45-degree field of view. Fundus photo.
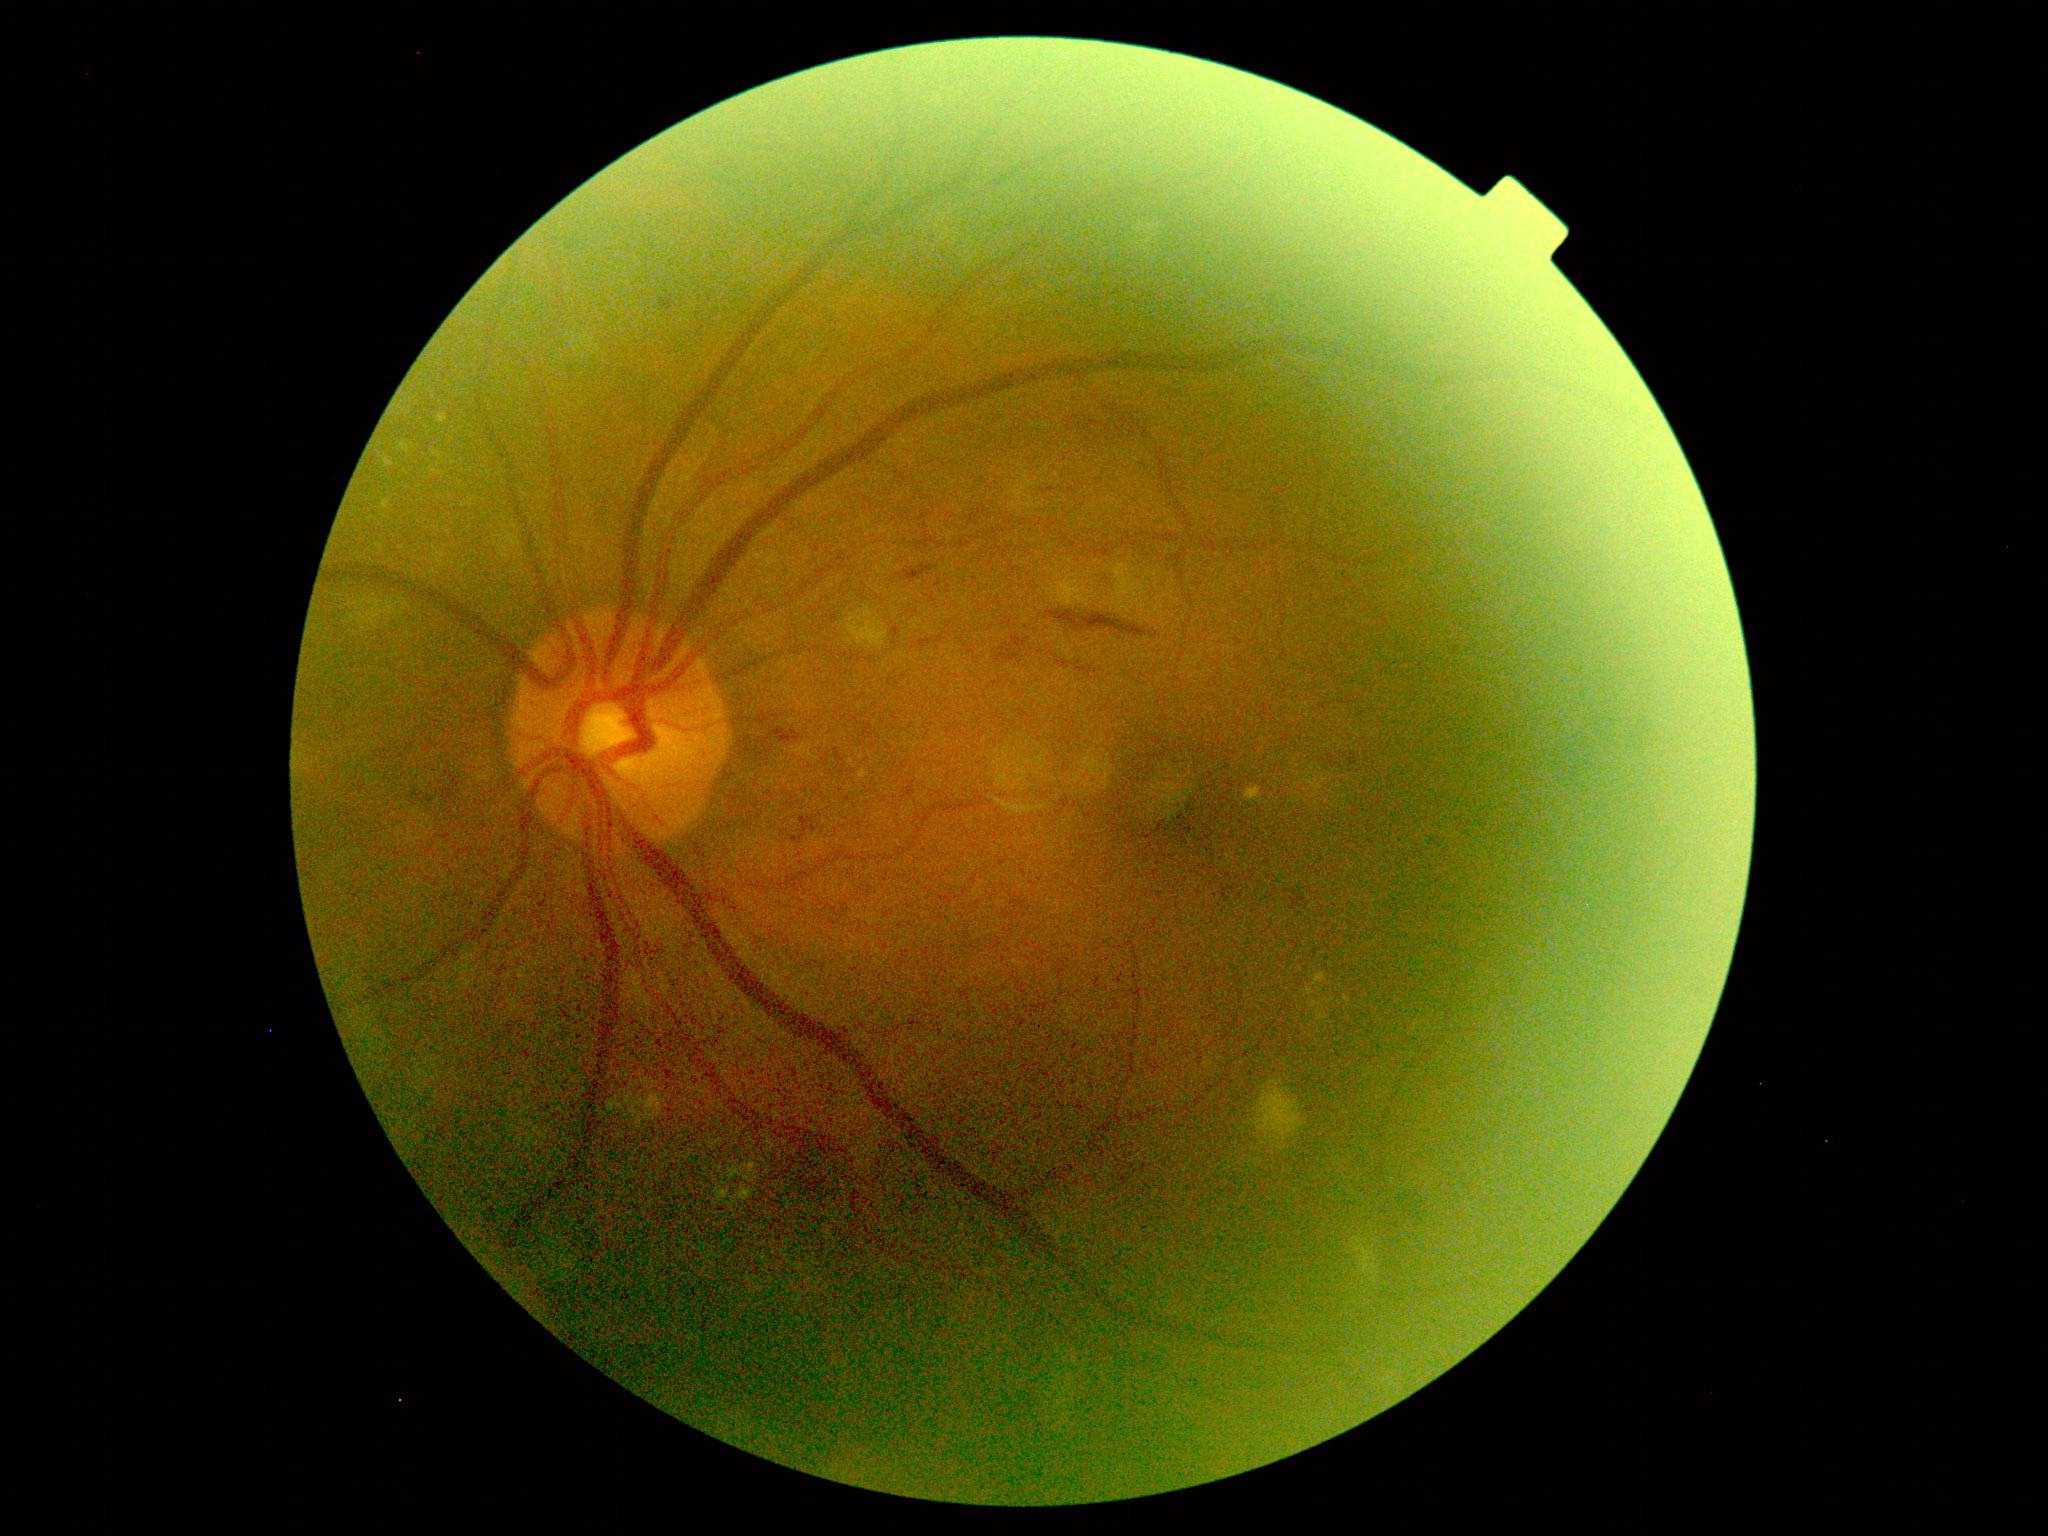 dr_grade: 2